Color fundus photograph.
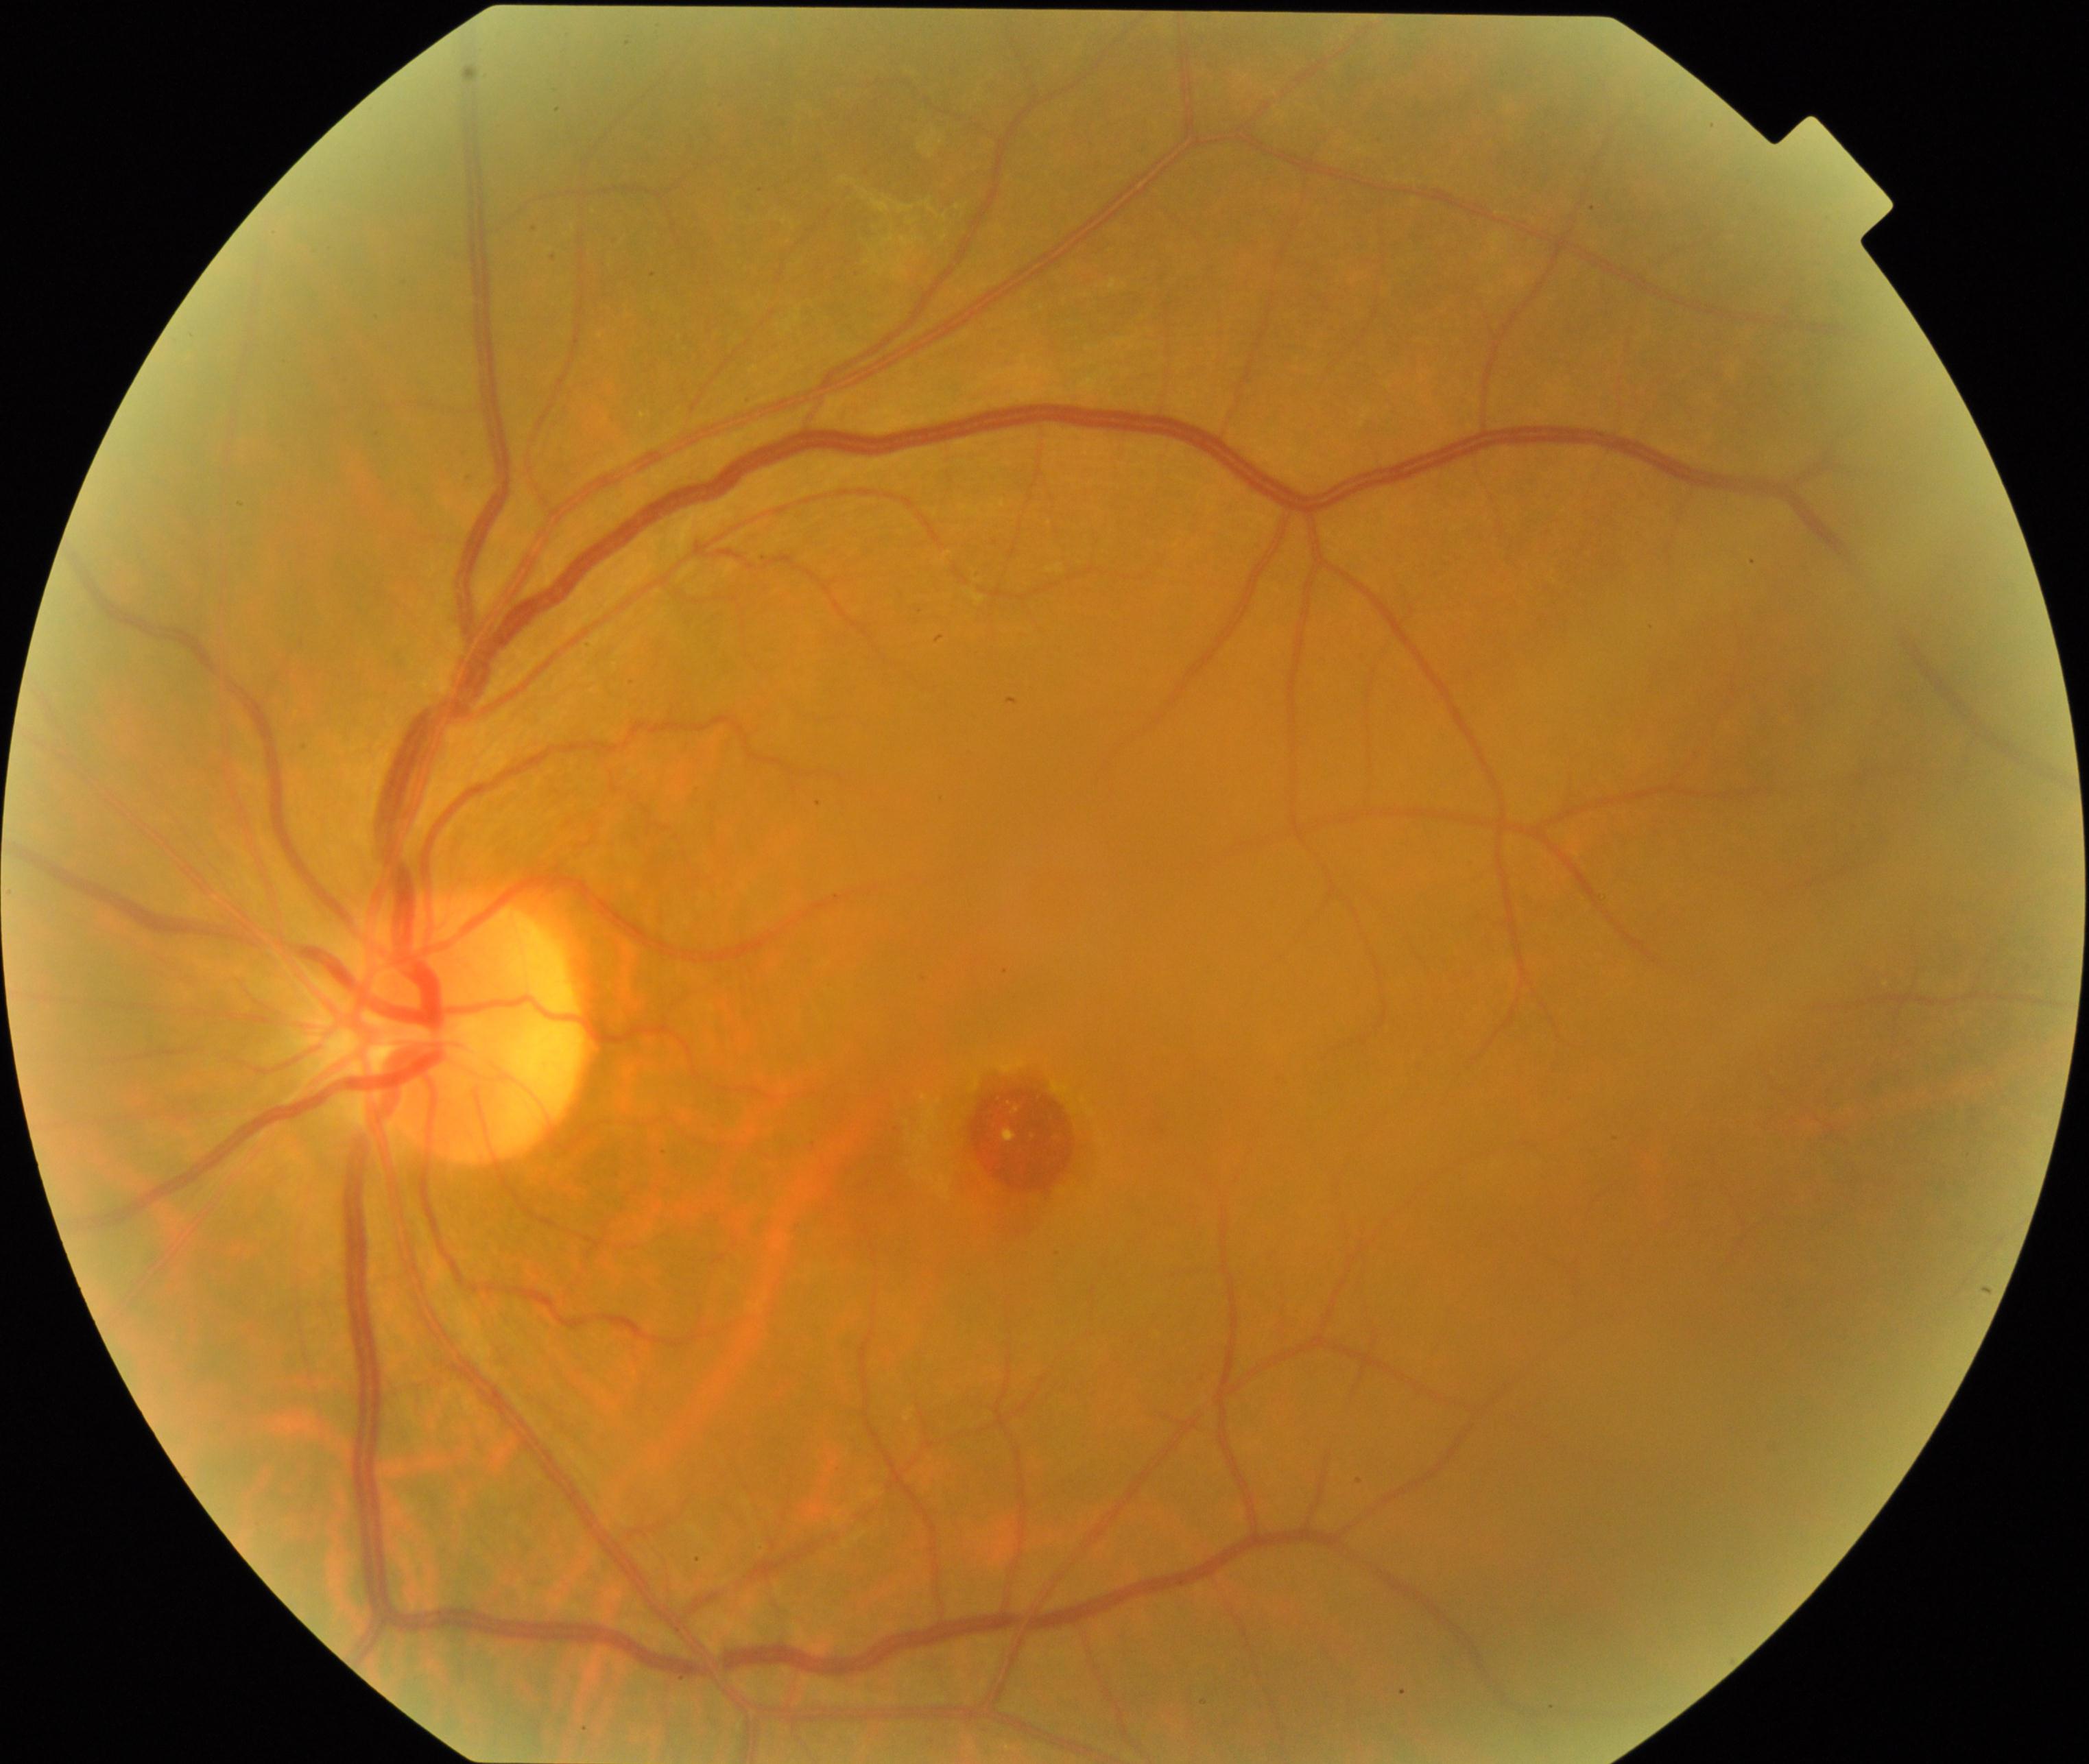

Primary finding: macular hole.